DR severity per modified Davis staging:
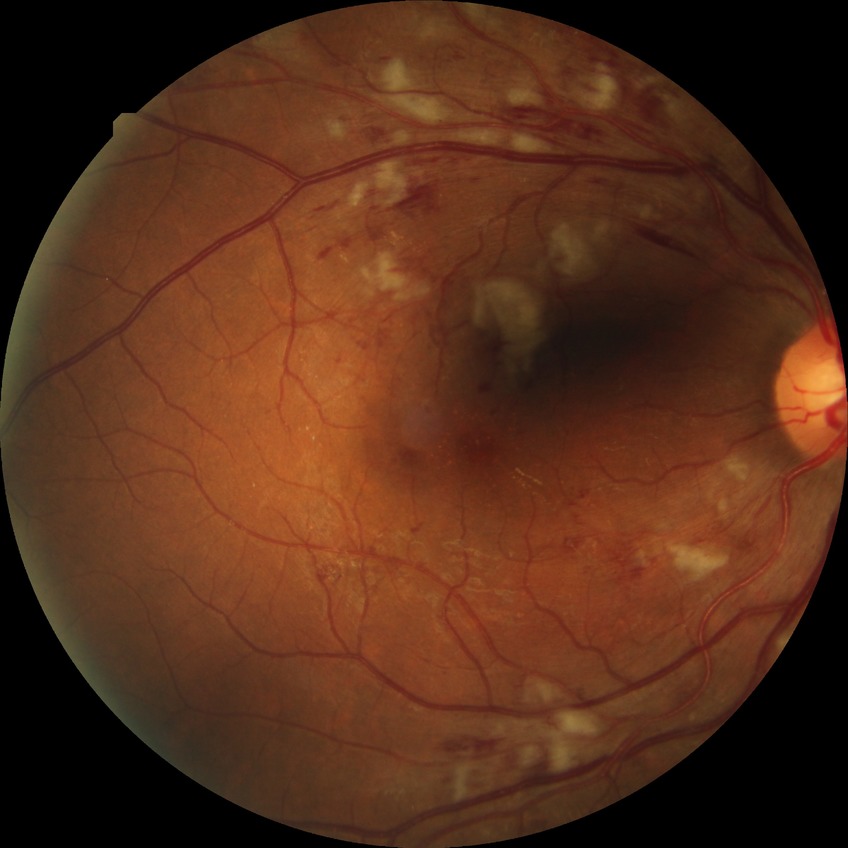
Diabetic retinopathy (DR) is PPDR (pre-proliferative diabetic retinopathy). Disease class: non-proliferative diabetic retinopathy.